45° field of view · 2048 x 1536 pixels:
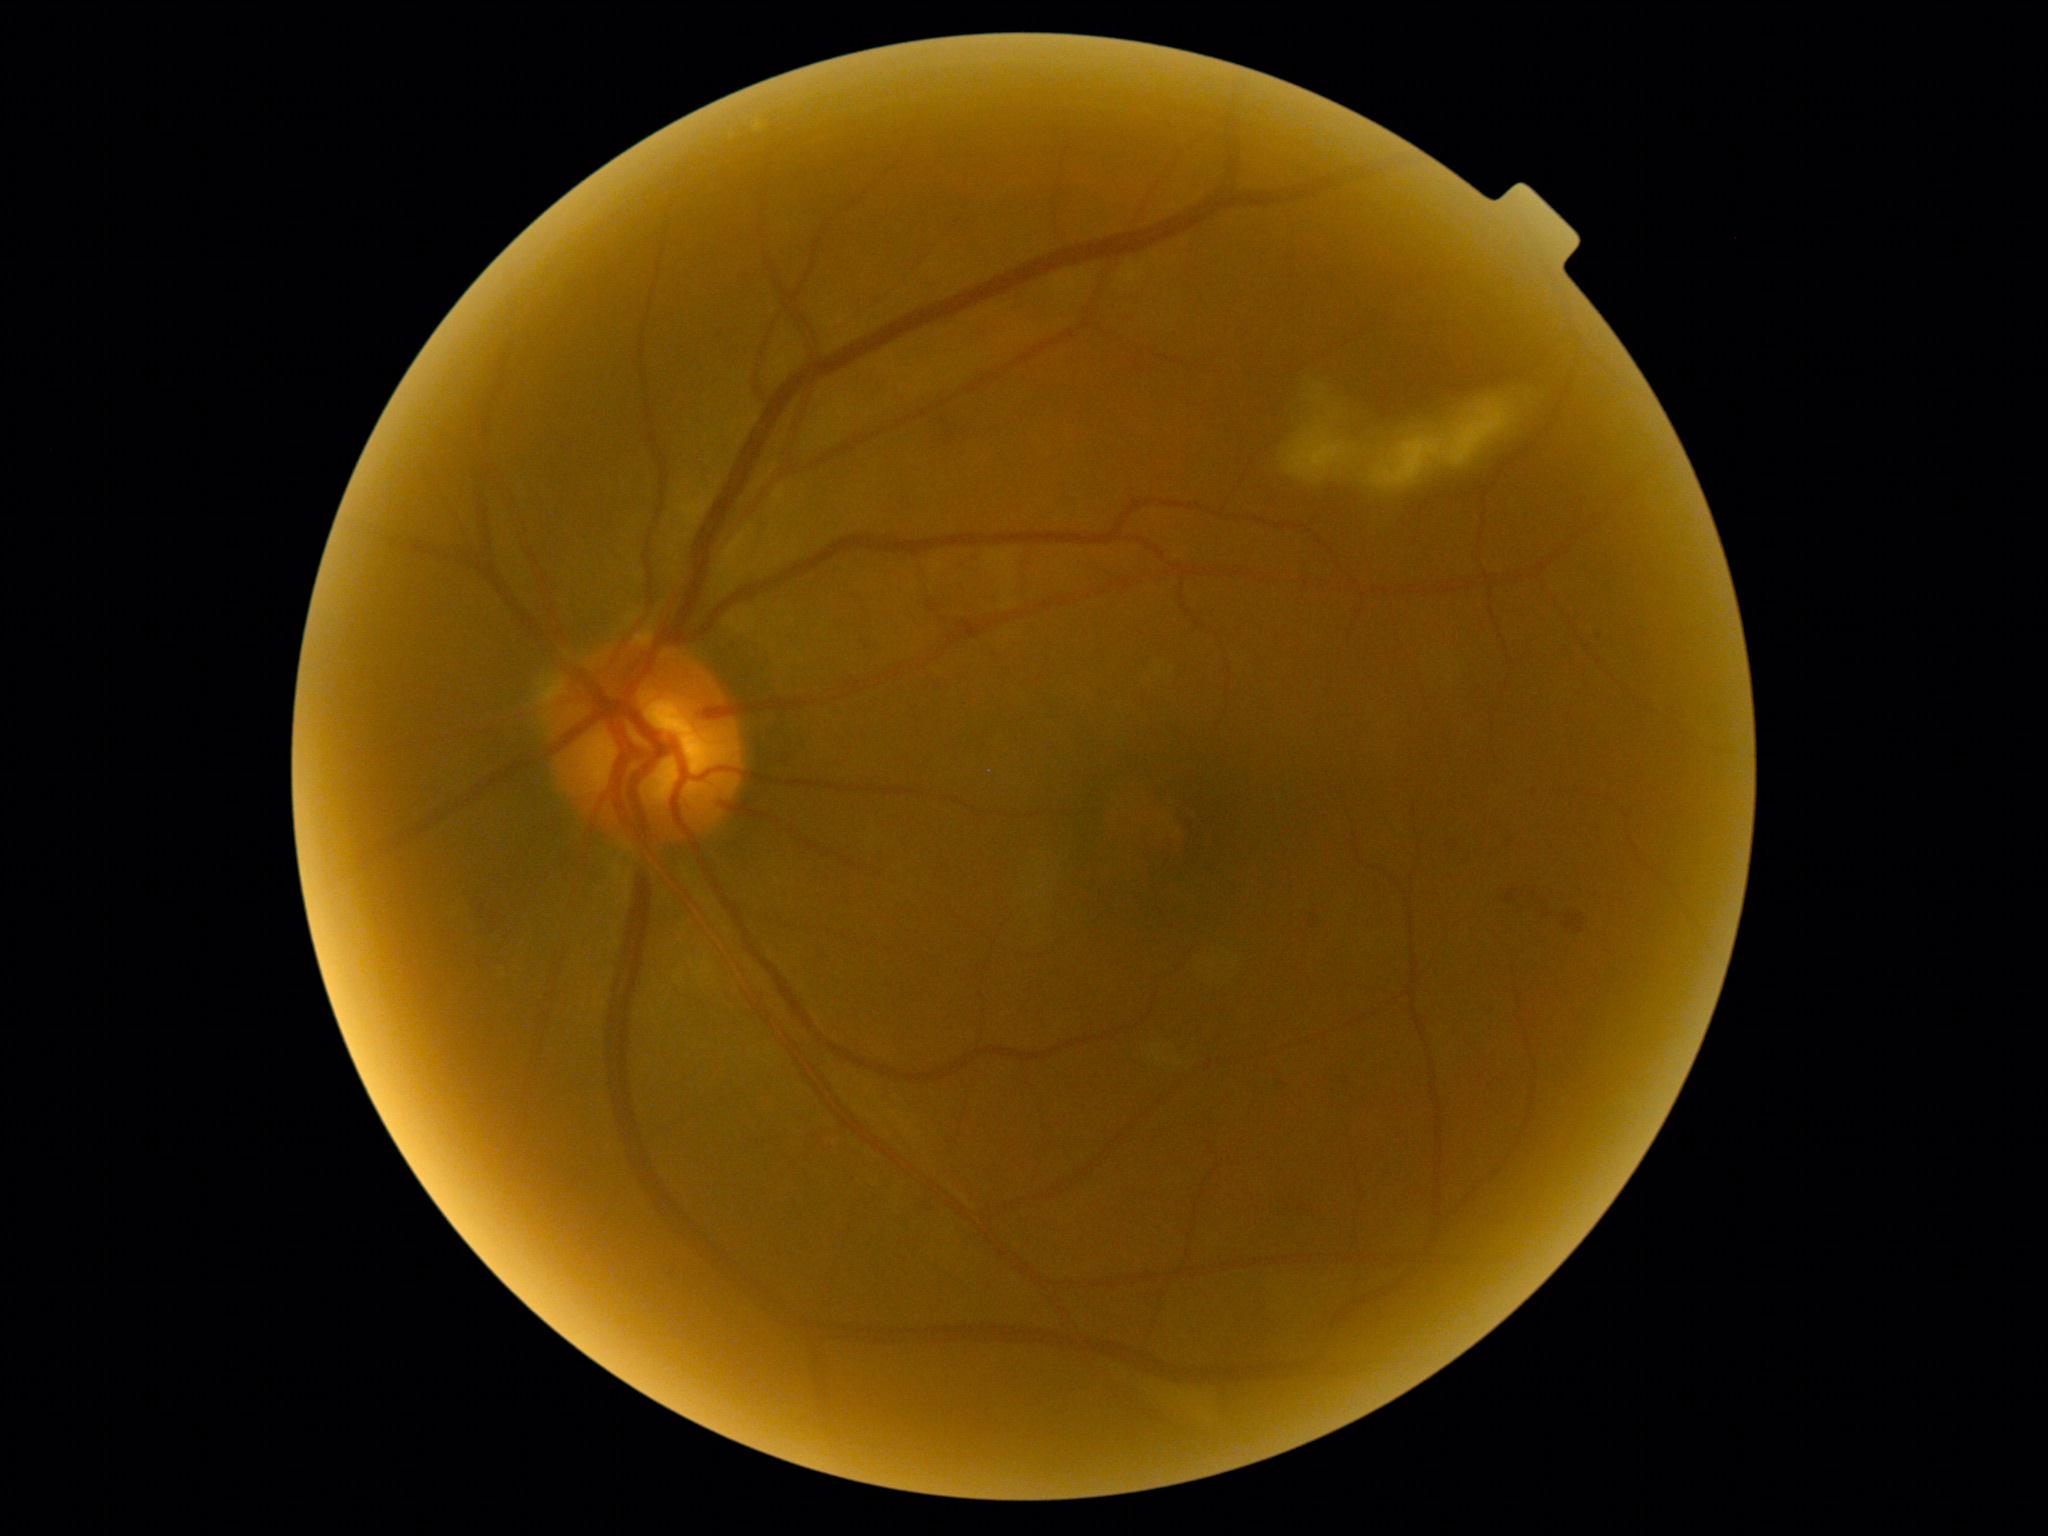

Annotations:
* diabetic retinopathy severity — grade 2 (moderate NPDR)